Acquired with a NIDEK AFC-230, no pharmacologic dilation: 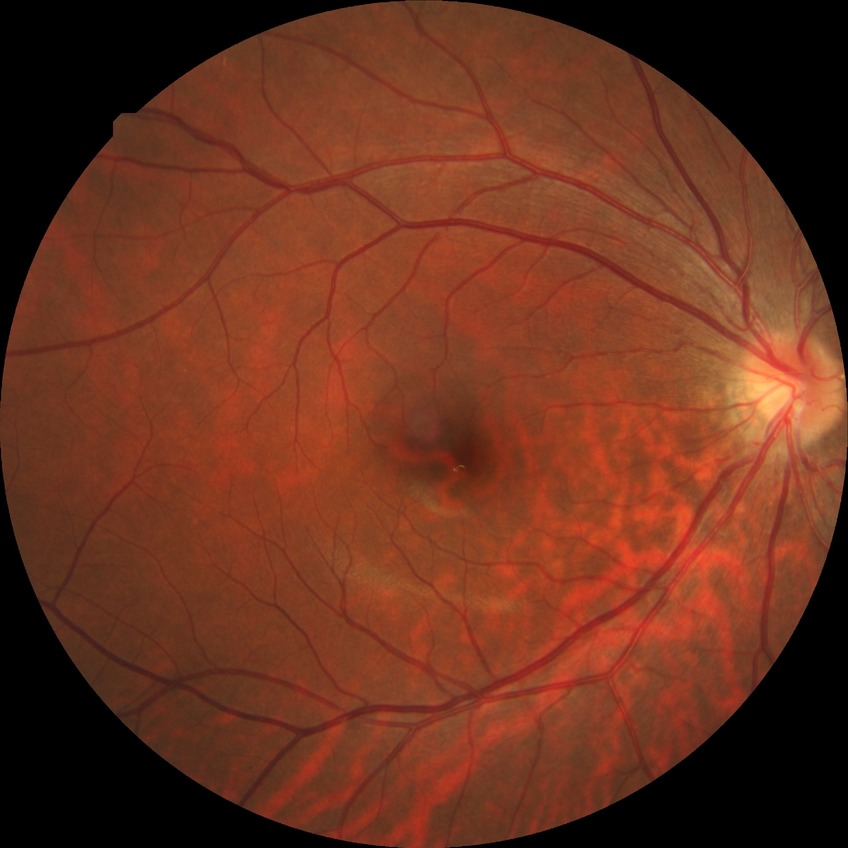 Diabetic retinopathy (DR) is NDR (no diabetic retinopathy).